45° FOV. 2352 x 1568 pixels — 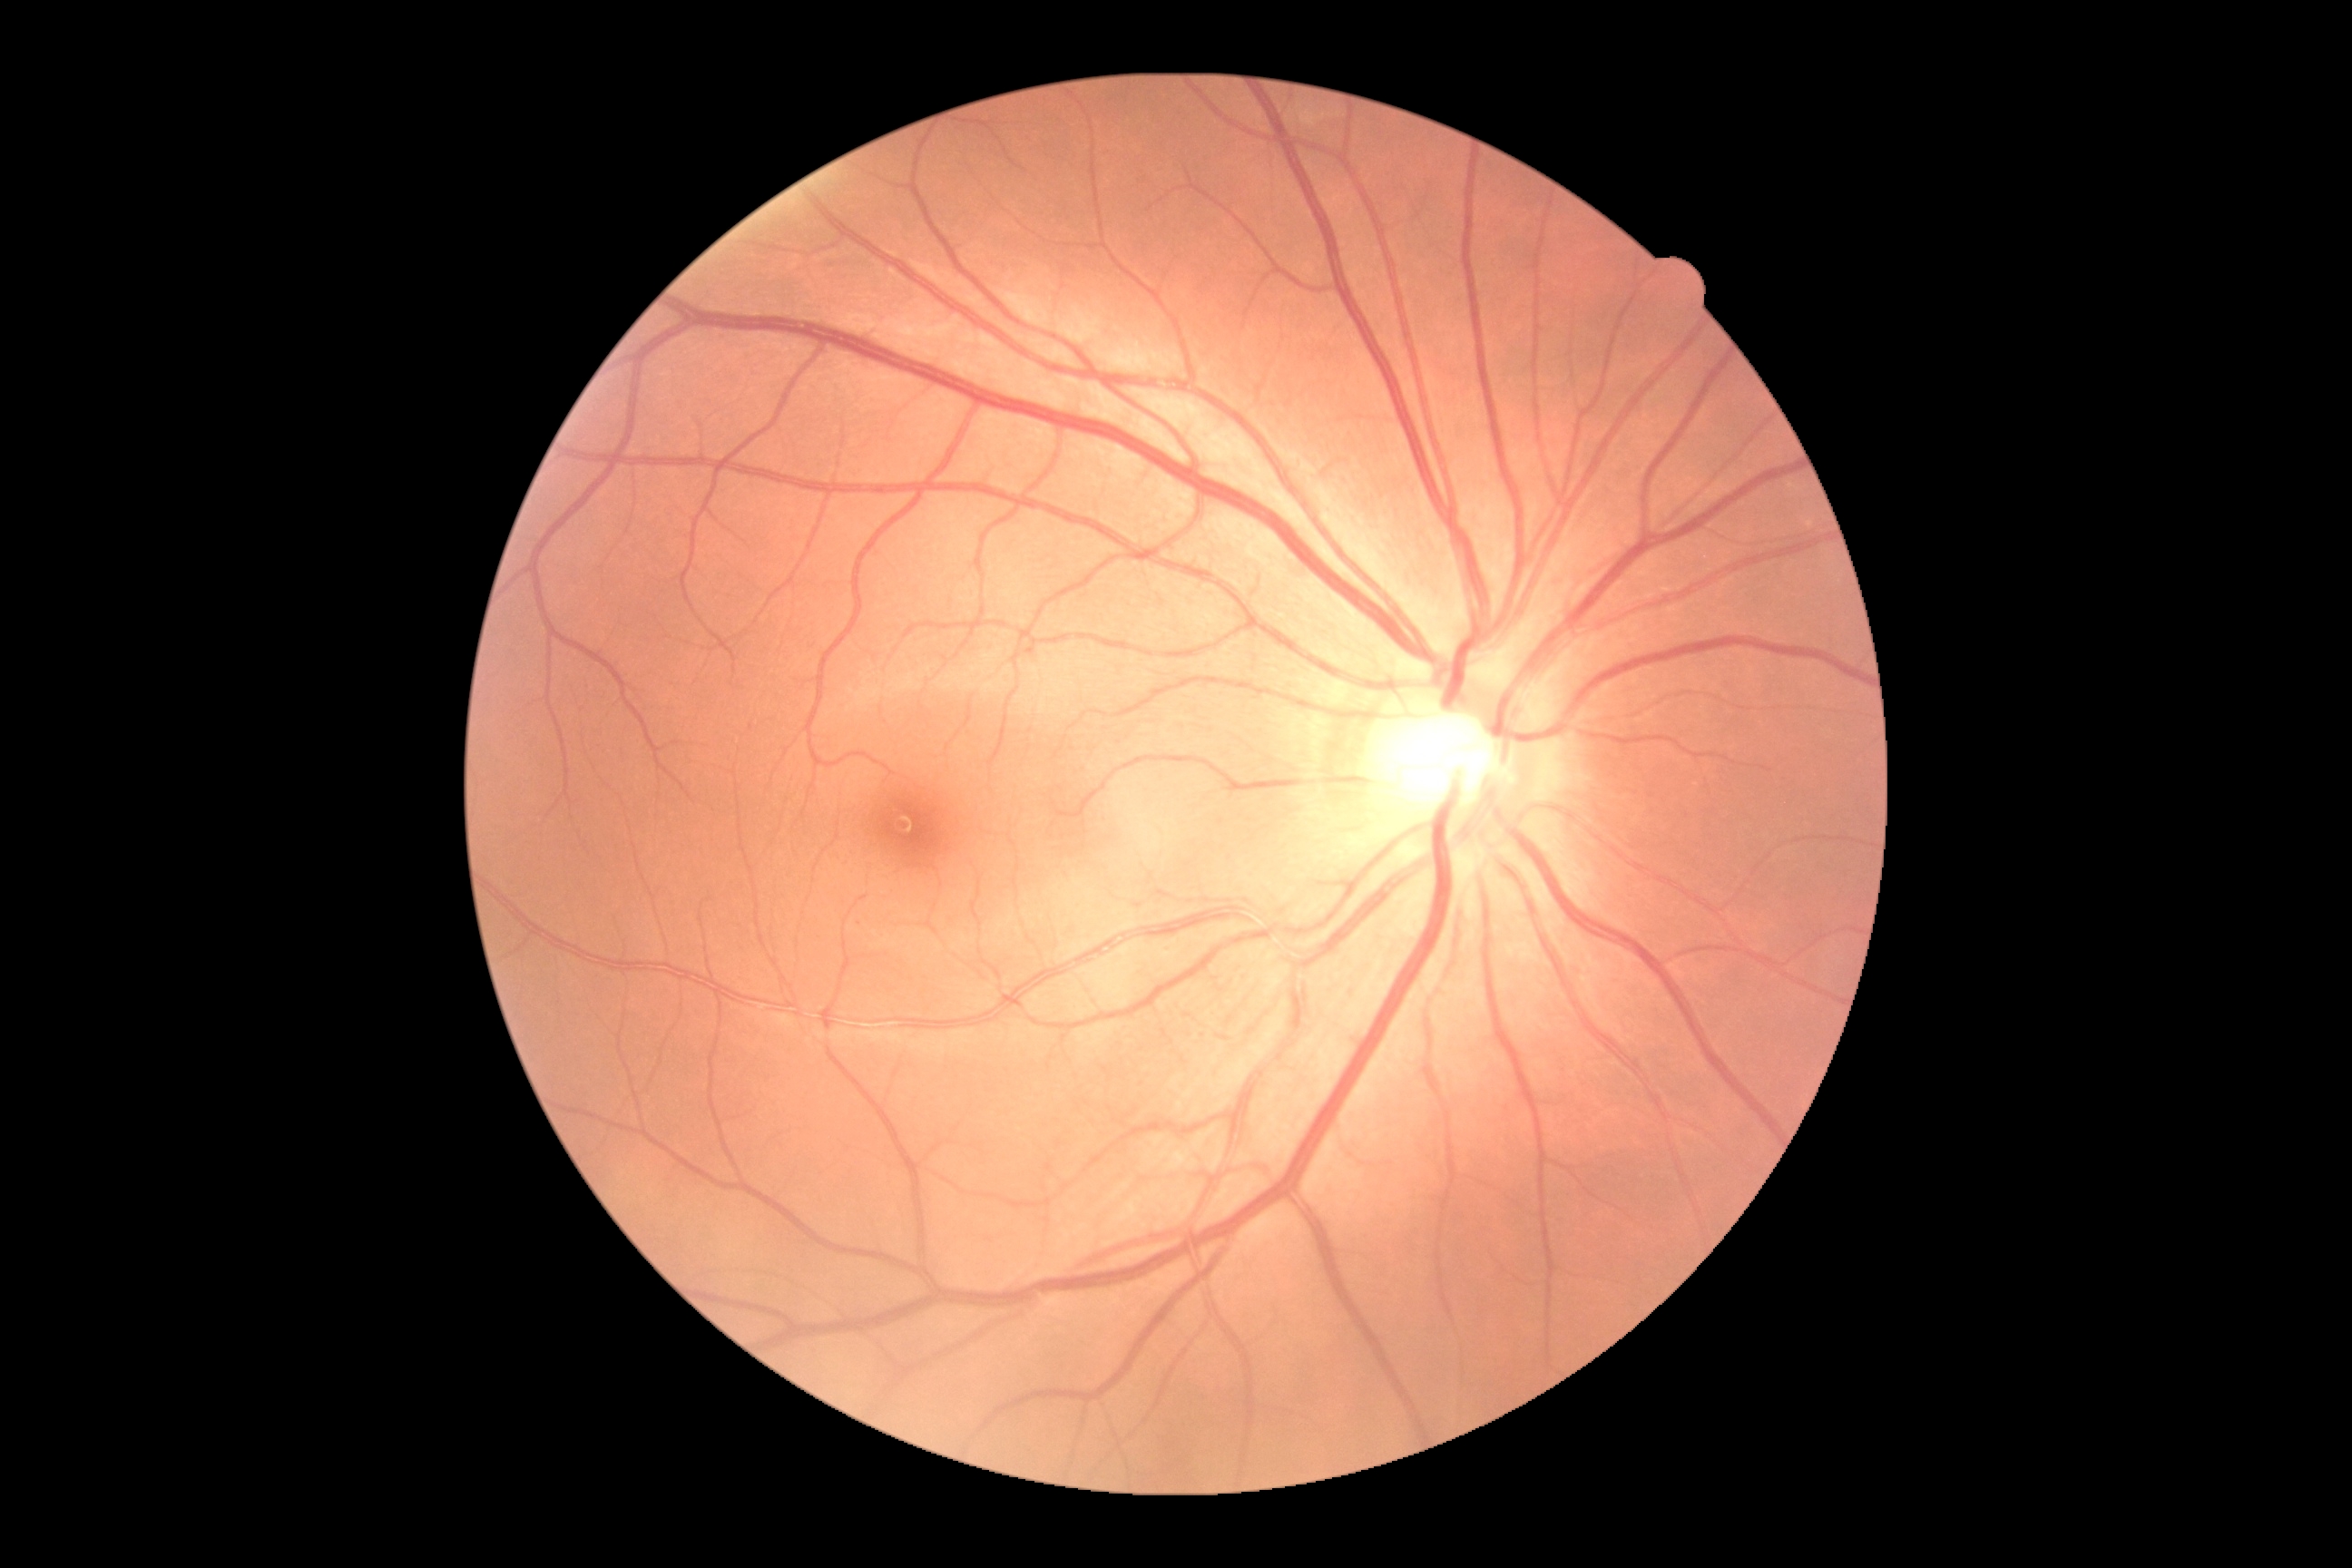 DR stage is 0.